Color fundus image.
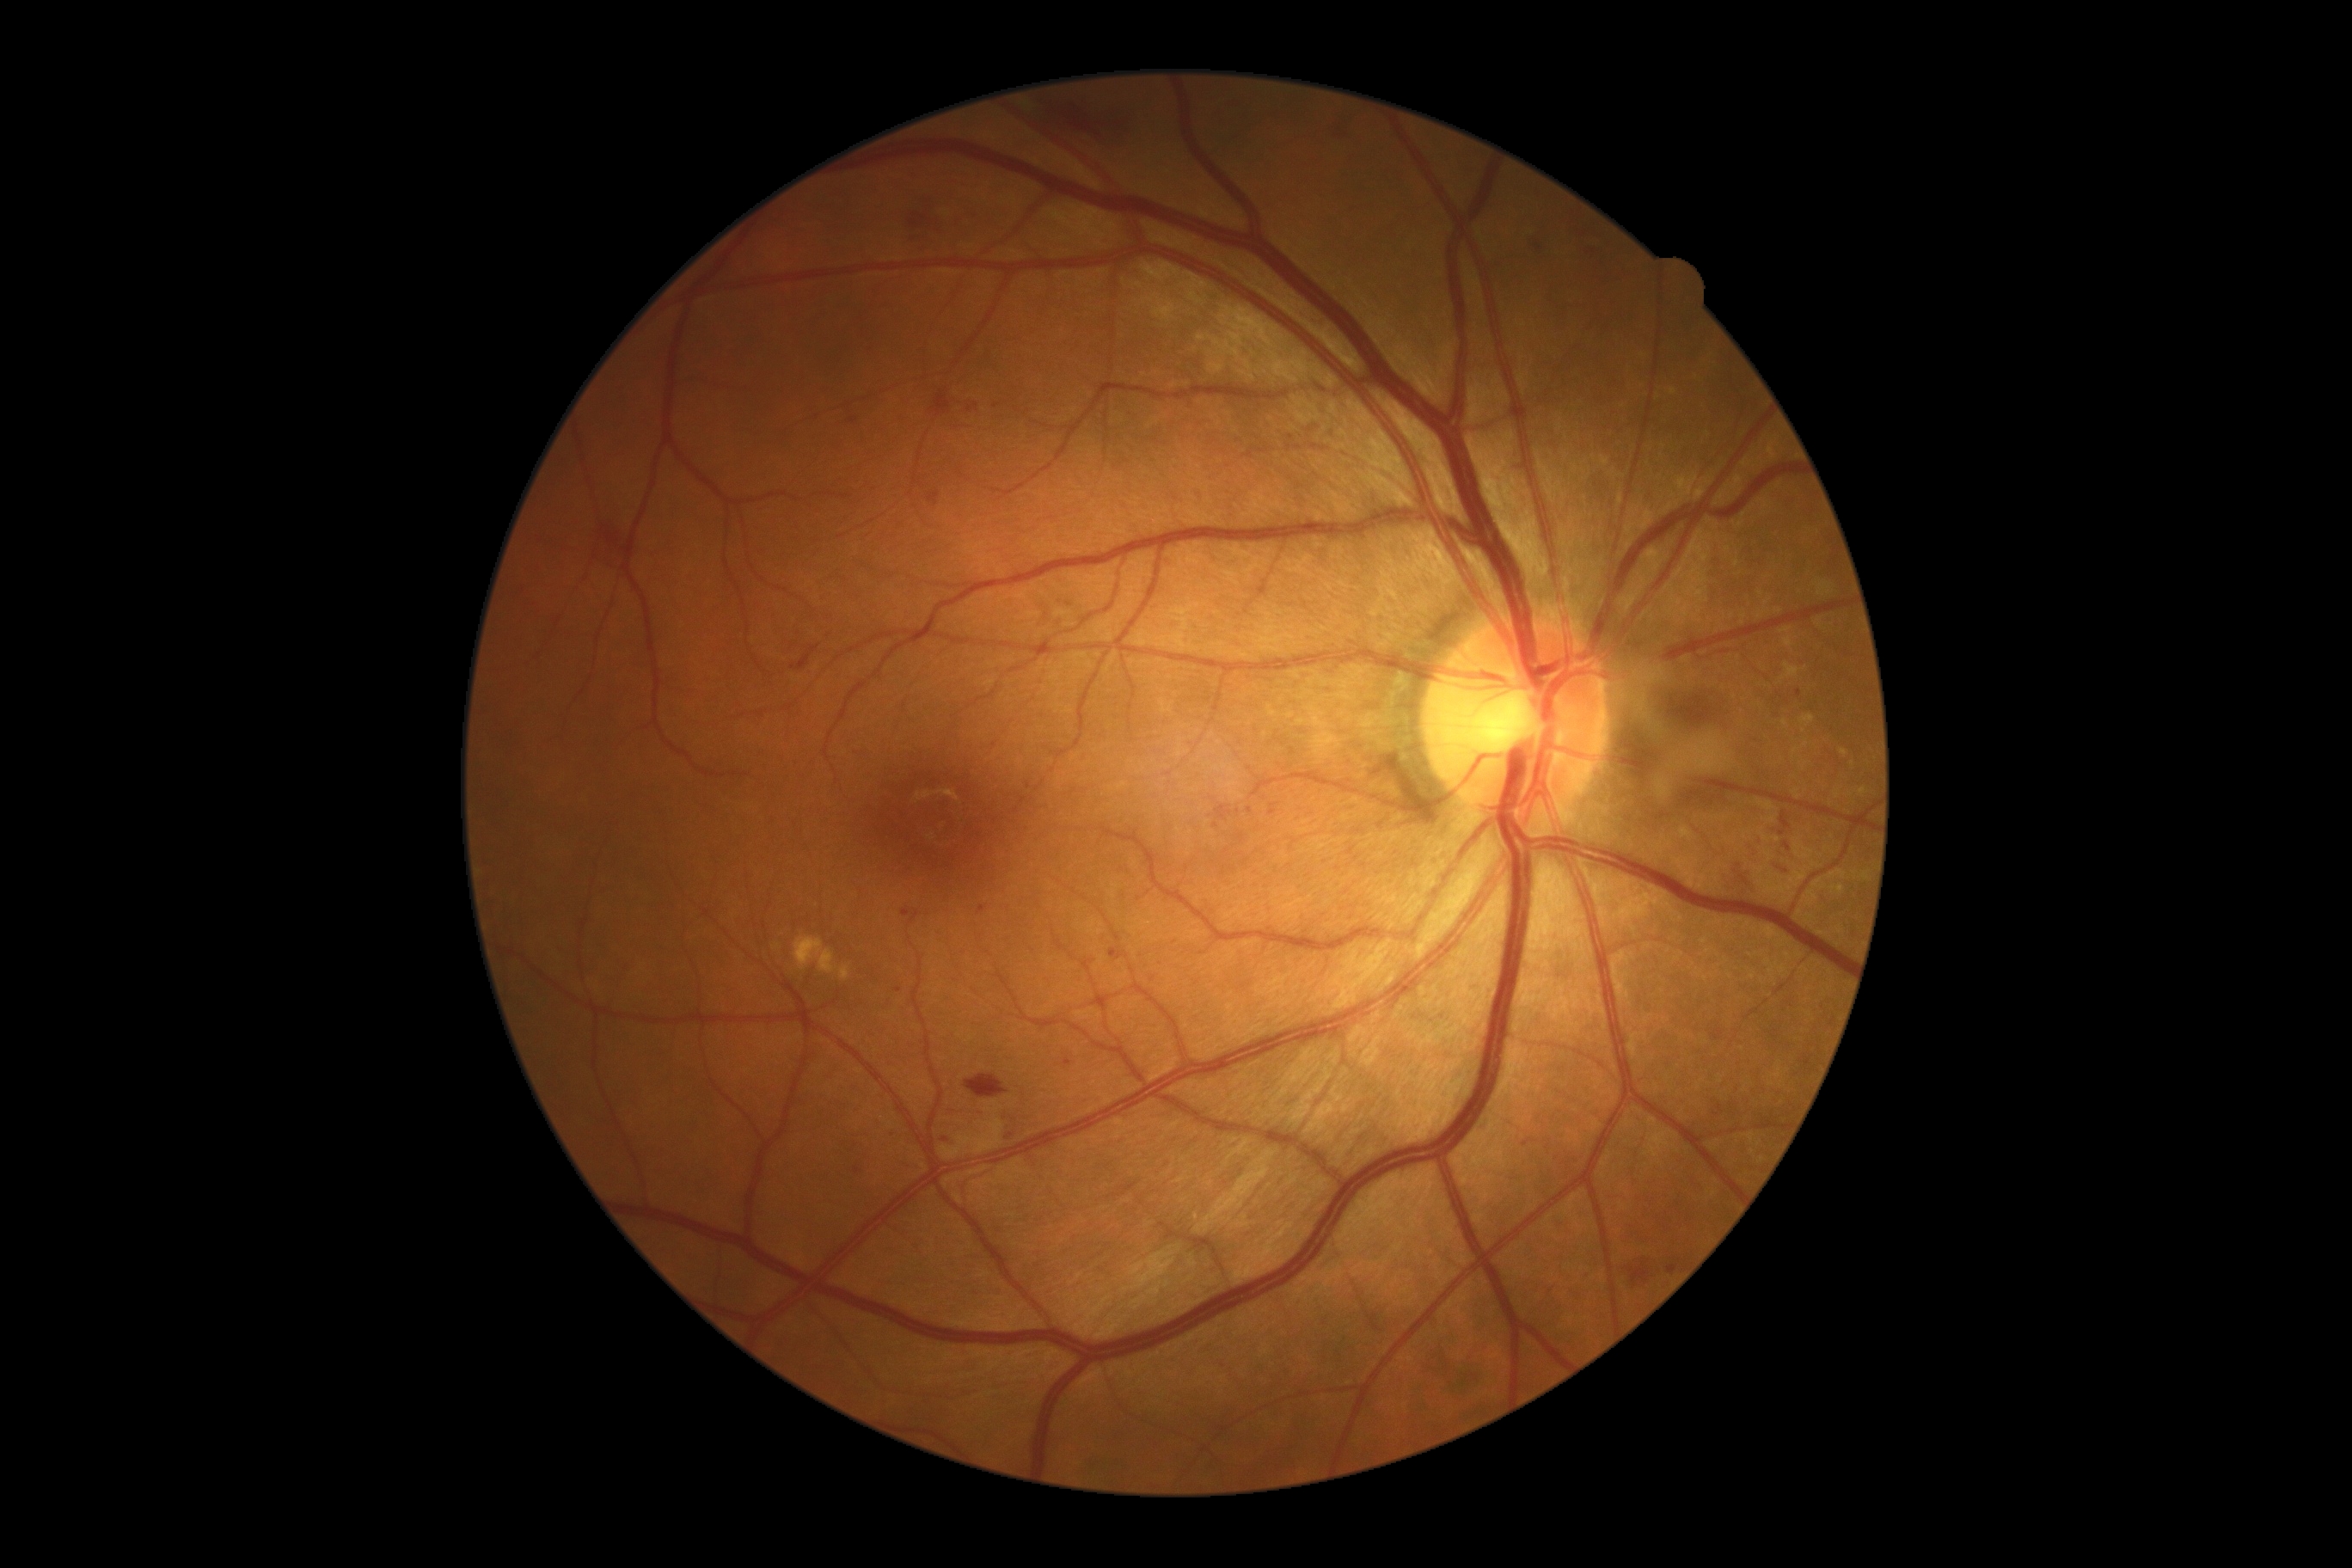 DR stage: 2/4. HEs include lesions at 1667, 1261, 1679, 1277; 1722, 864, 1761, 895; 1779, 840, 1796, 861; 988, 400, 1001, 410; 890, 1130, 898, 1139; 1748, 835, 1765, 859; 902, 907, 910, 917; 1335, 111, 1361, 137; 905, 195, 989, 254; 934, 393, 984, 422; 1215, 805, 1232, 821; 854, 1167, 862, 1173; 928, 491, 941, 506; 1063, 1060, 1072, 1069; 1629, 1261, 1657, 1290. HEs (small, approximate centers) near pt(1250, 810); pt(1216, 826); pt(1029, 786); pt(1291, 438).